Centered on the optic disc — 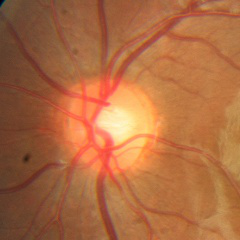 Diagnosis: no glaucomatous changes.